848x848px. 45° field of view. Camera: NIDEK AFC-230. Without pupil dilation — 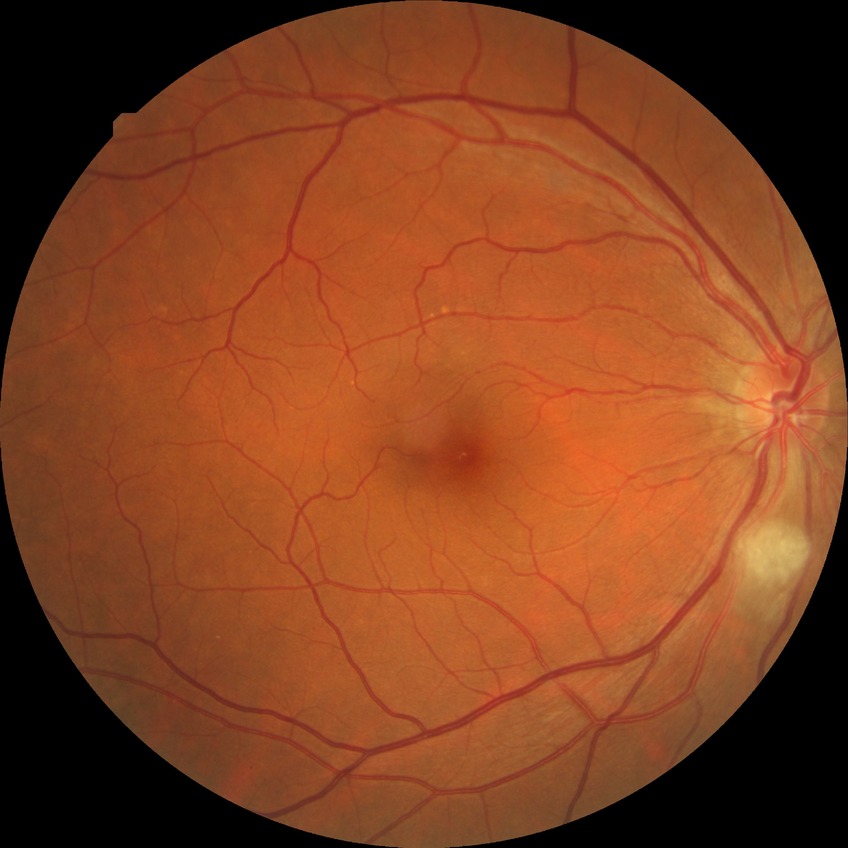 Diabetic retinopathy (DR): no diabetic retinopathy (NDR).